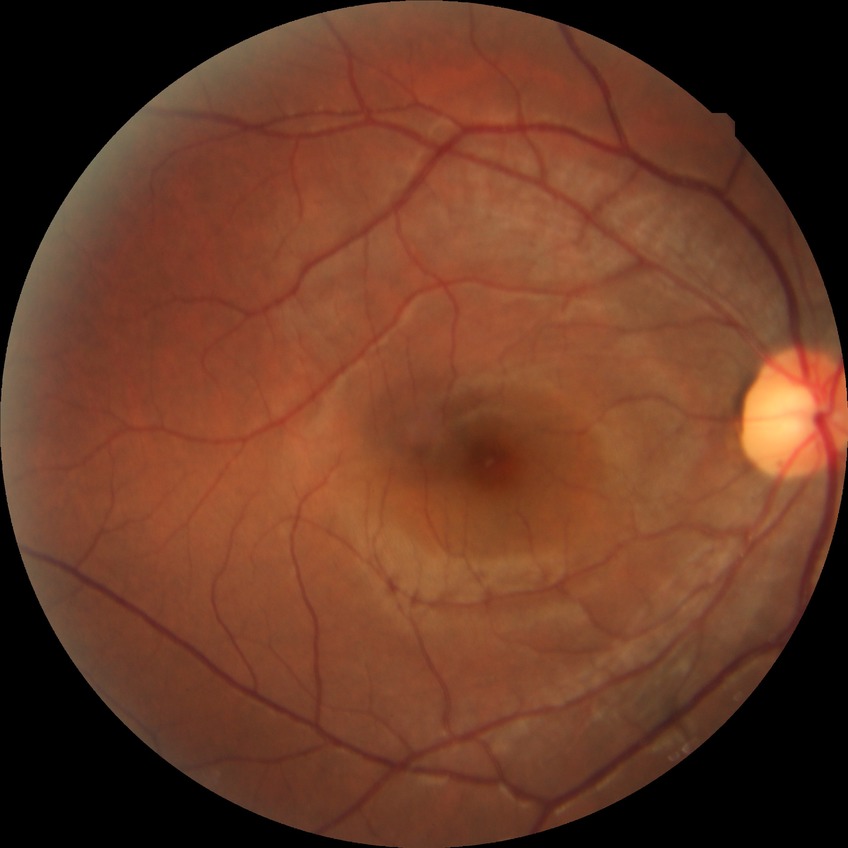
Diabetic retinopathy stage: no diabetic retinopathy.